Wide-field fundus photograph of an infant · captured with the Phoenix ICON (100° field of view): 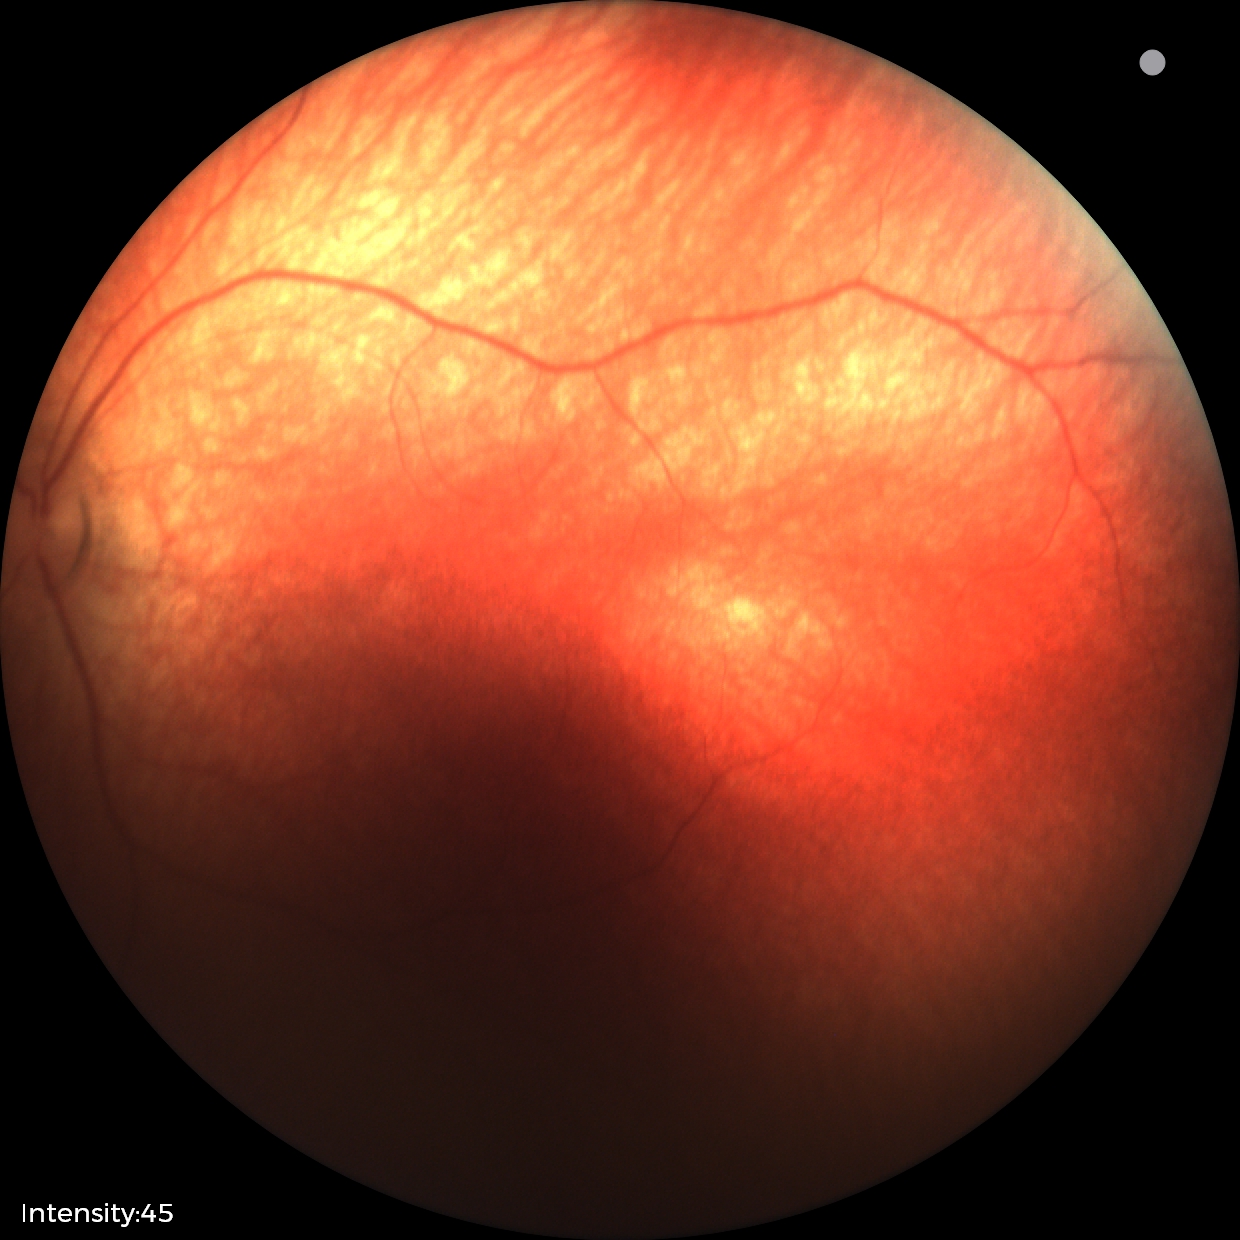

Physiological retinal appearance for postconceptual age.